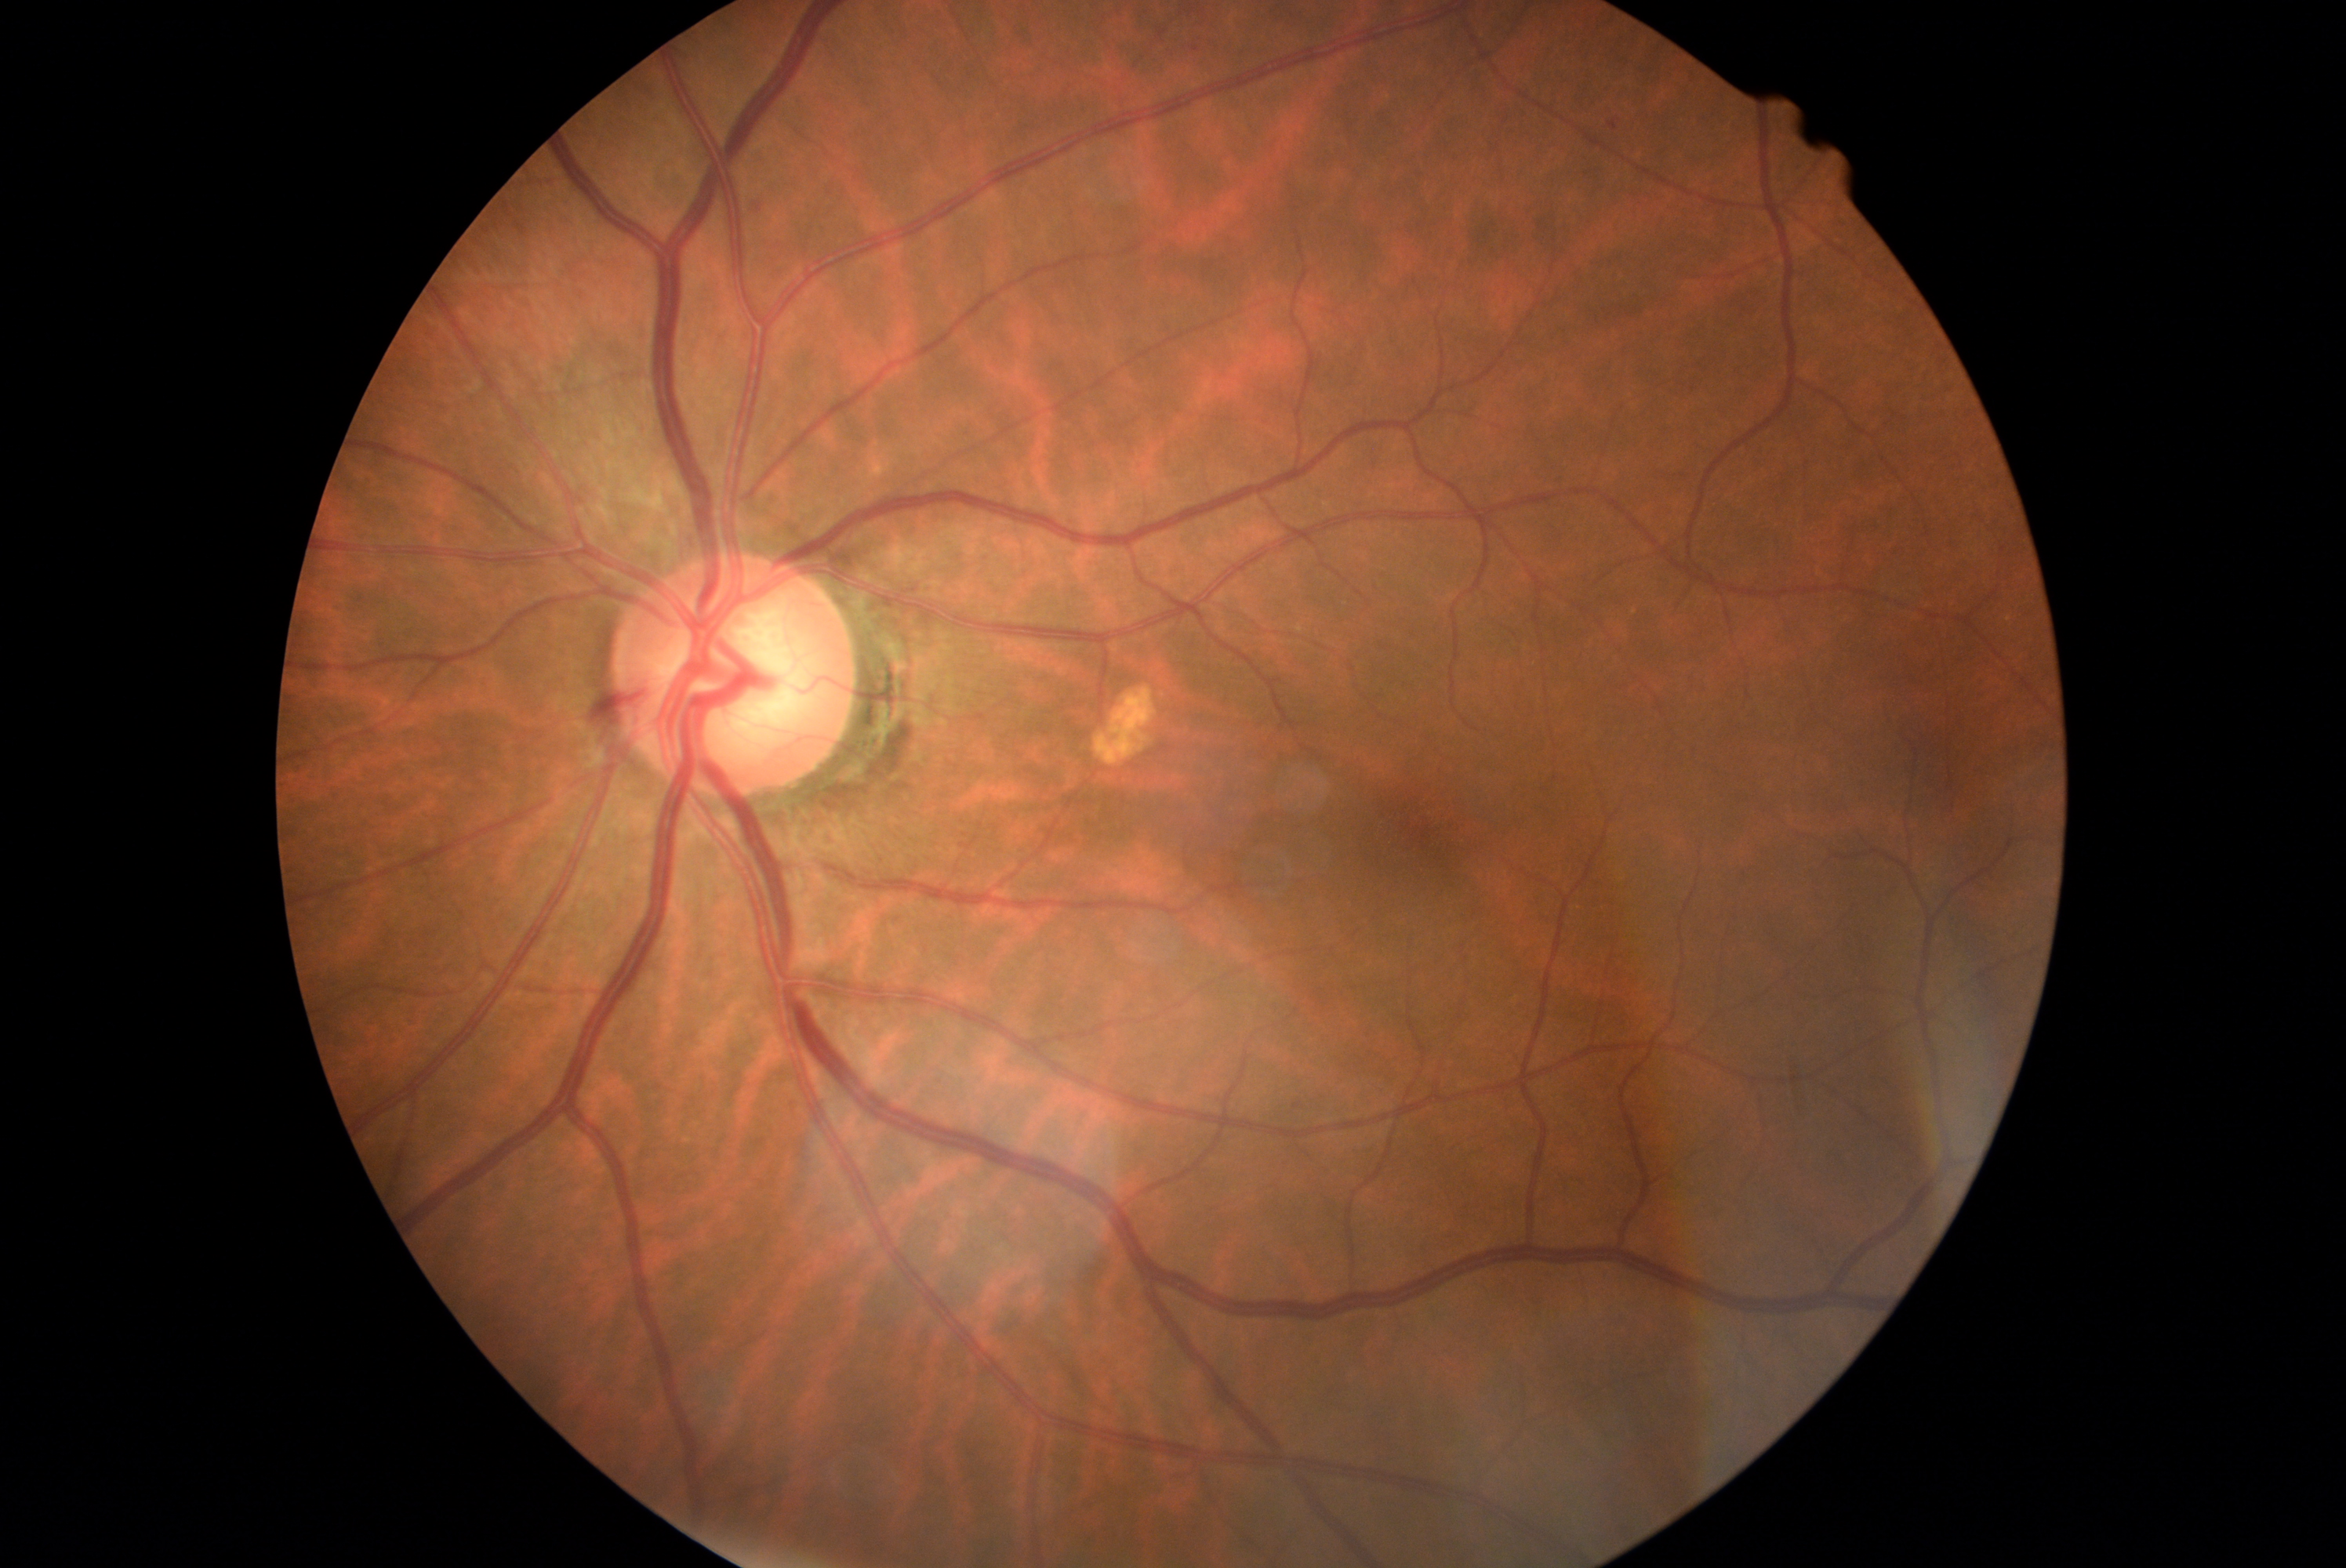
DR: moderate NPDR (grade 2).